Pediatric wide-field fundus photograph
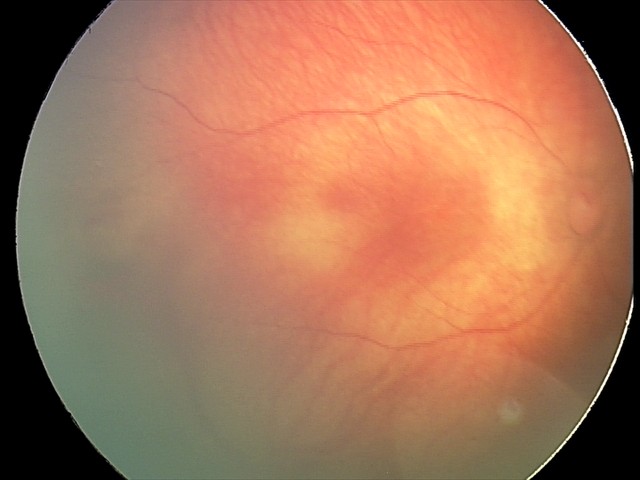

Series diagnosed as retinal hemorrhages.